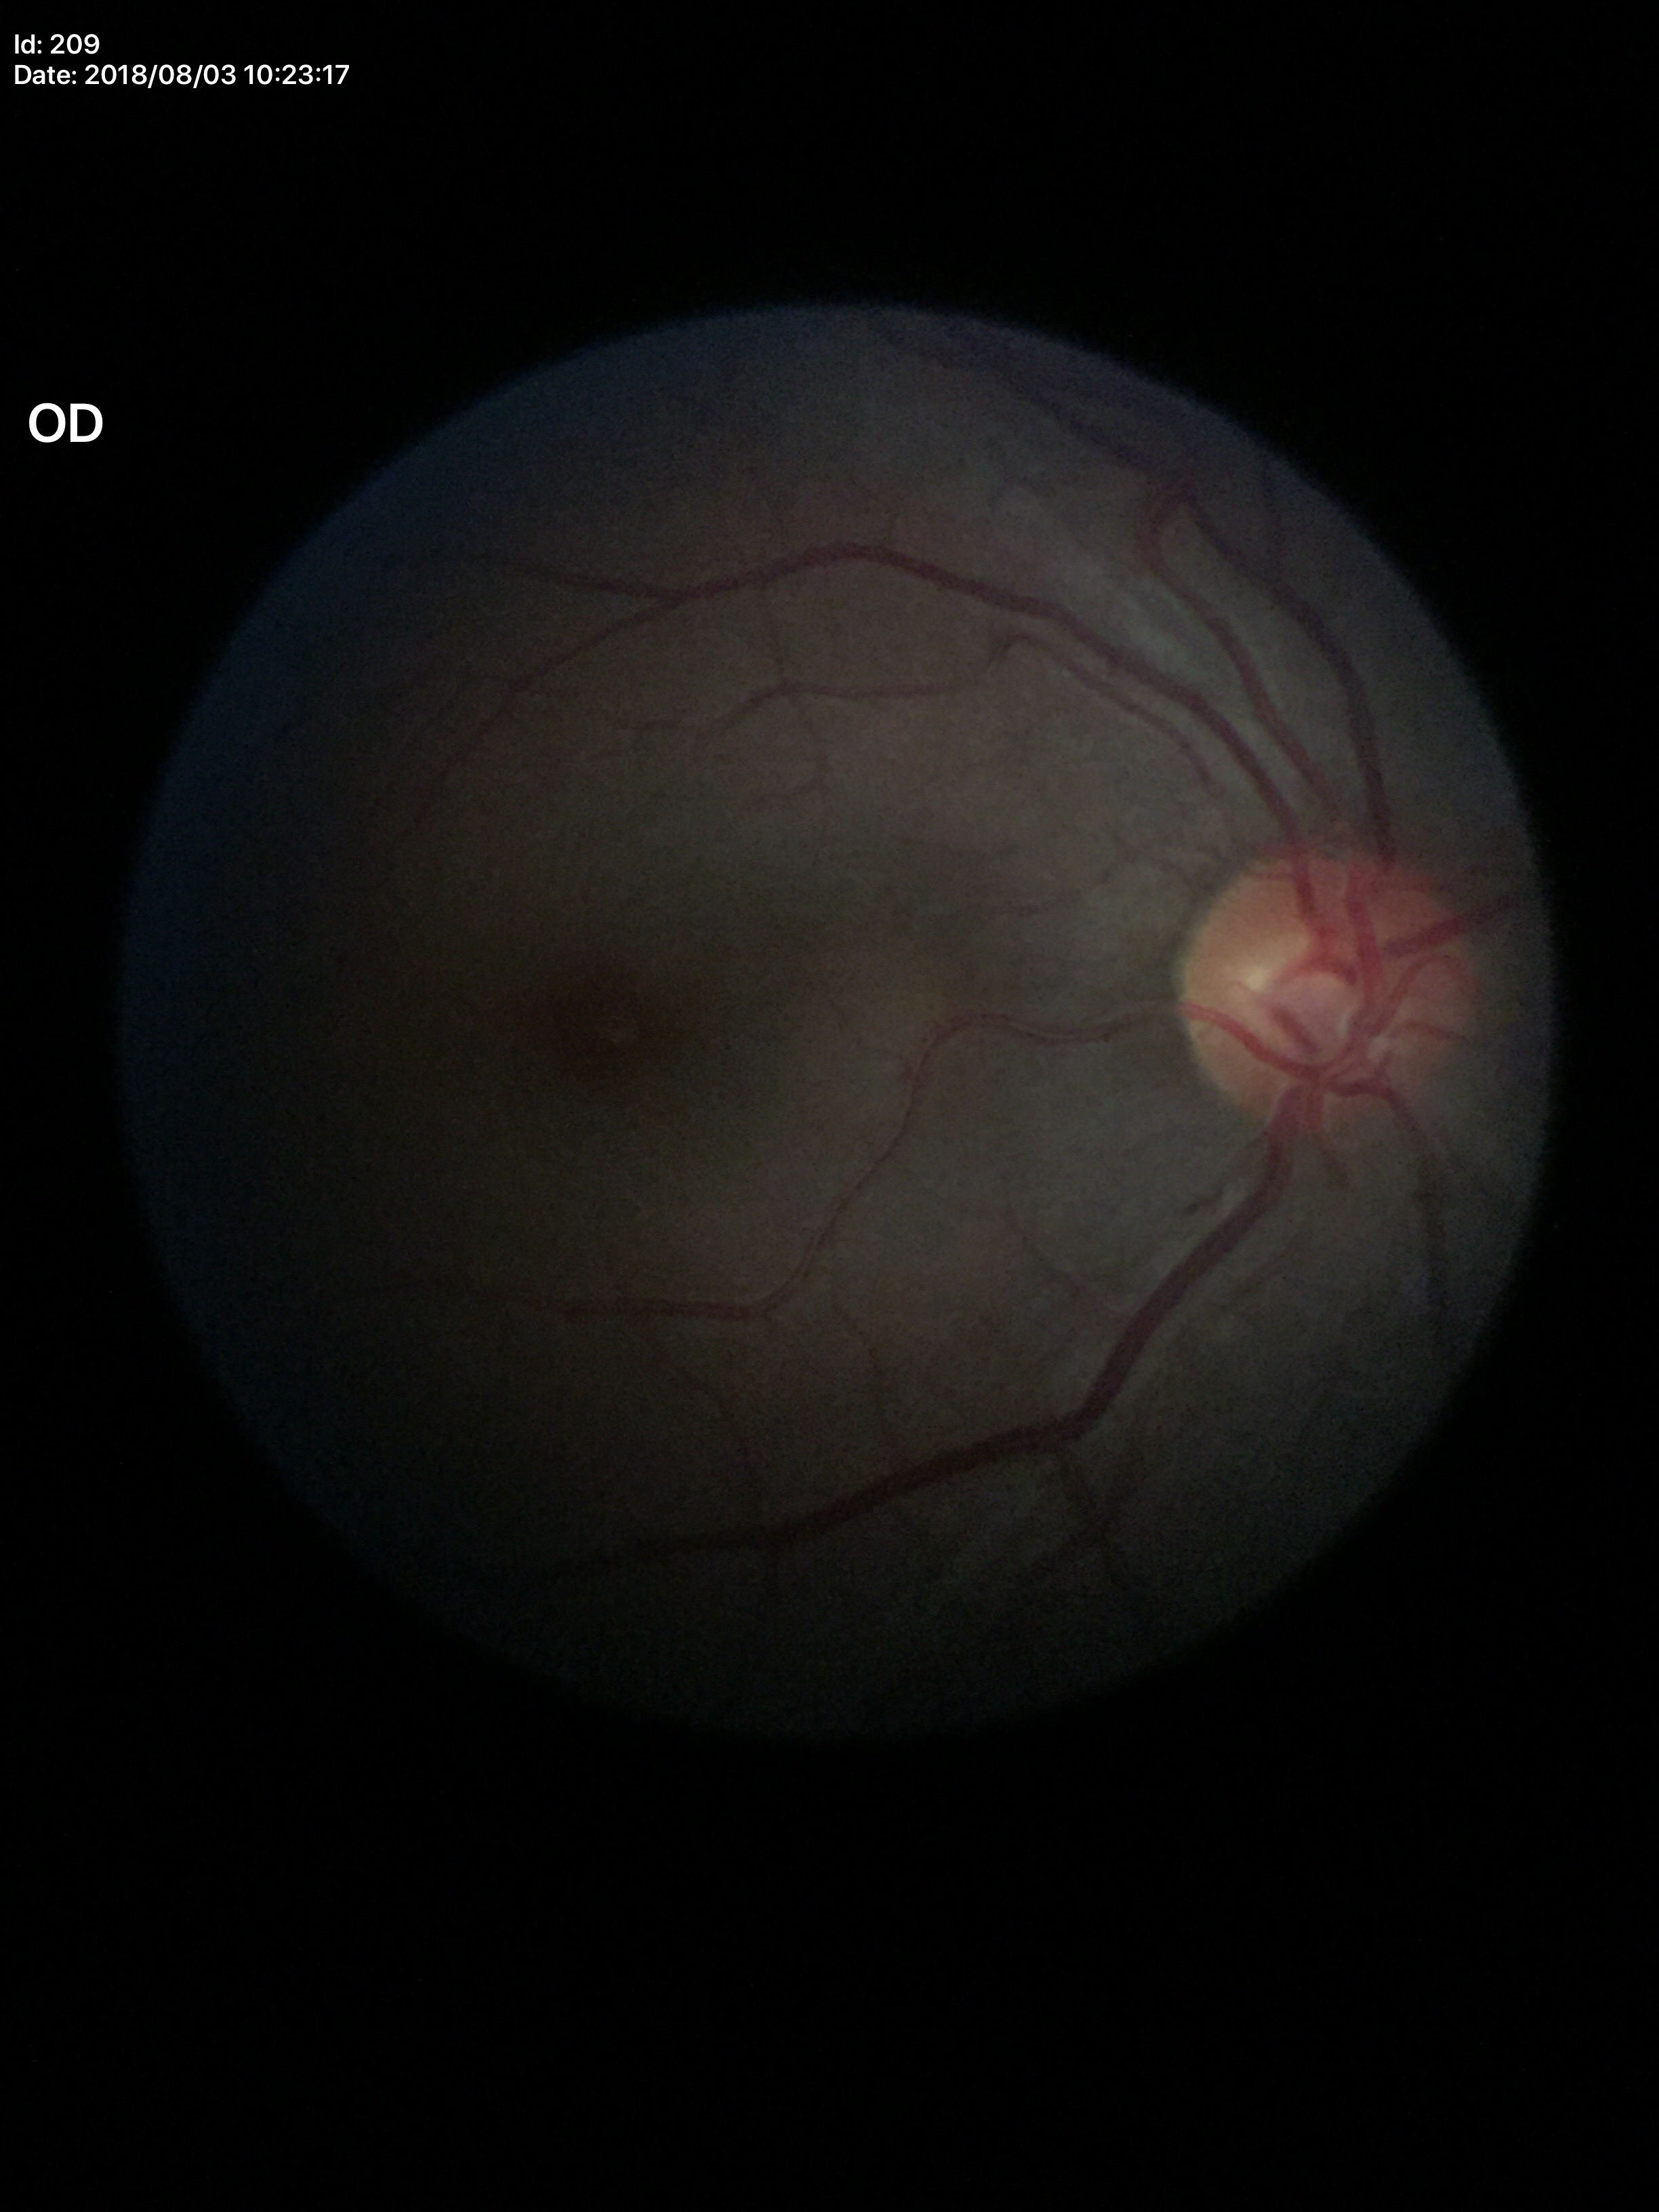
Glaucoma decision = negative (unanimous normal call), vertical C/D ratio = 0.46.